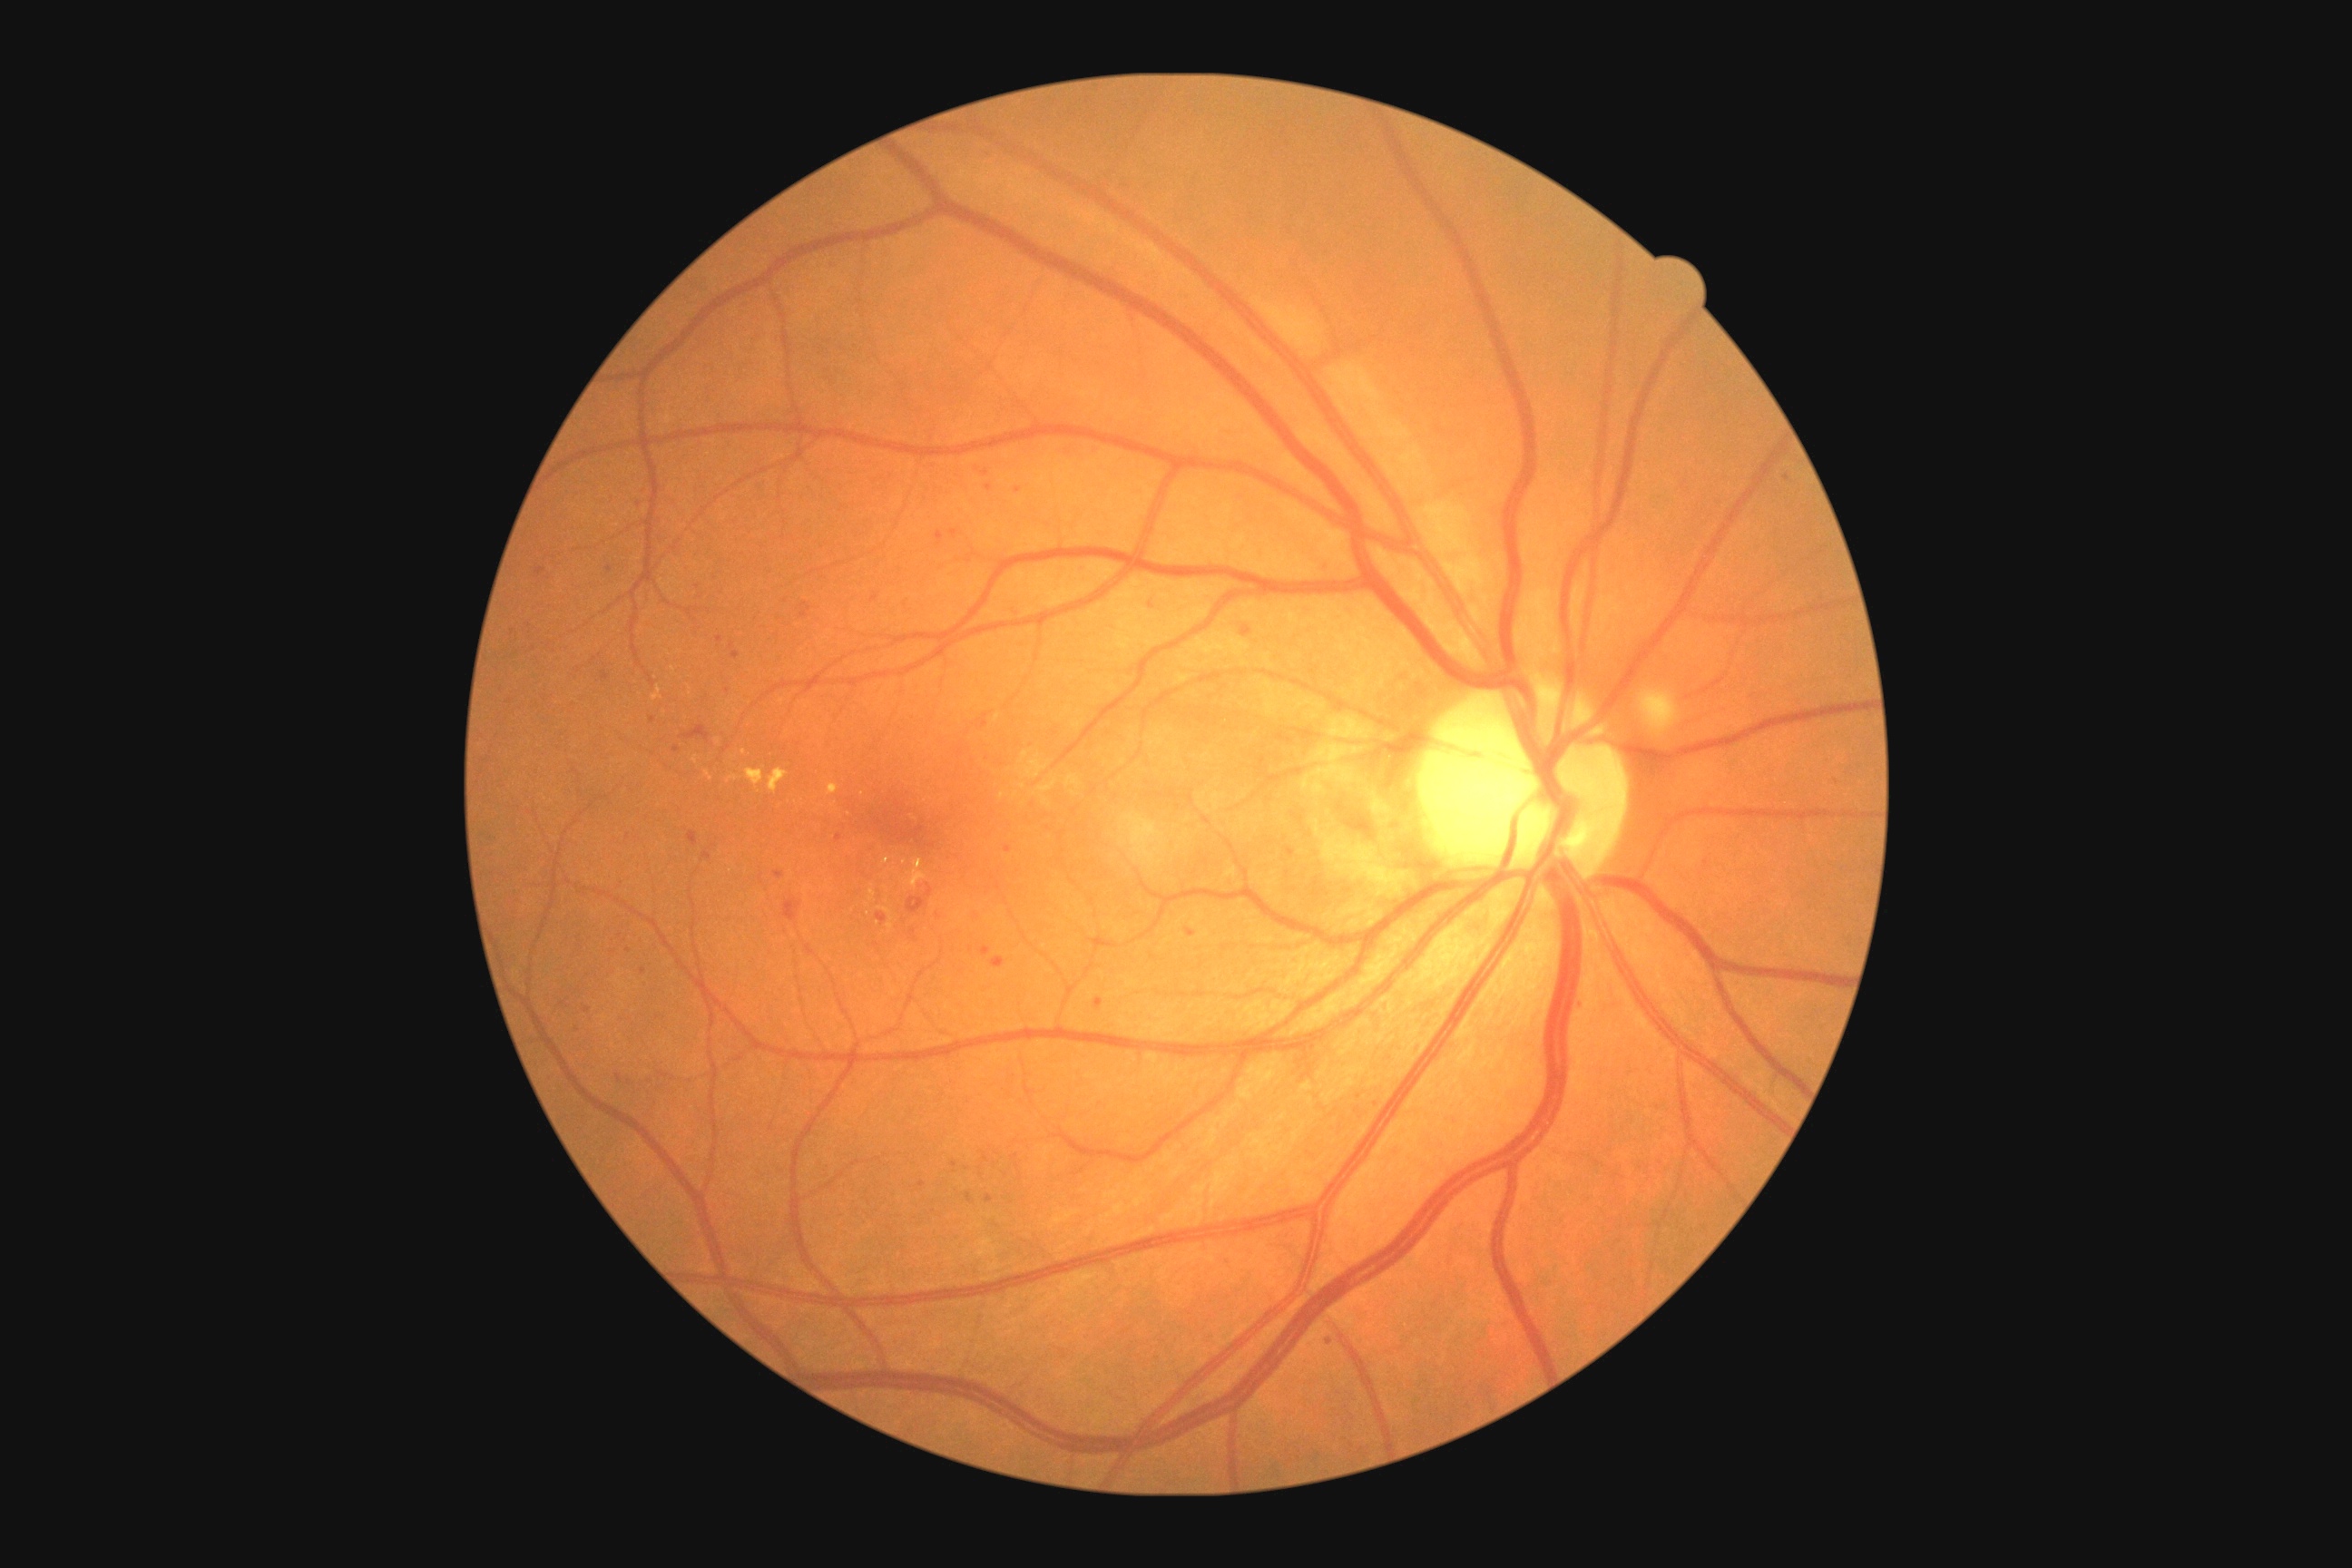

<lesions partial="true">
  <dr_grade>2</dr_grade>
  <ma partial="true">bbox=[836, 834, 843, 843]; bbox=[536, 567, 545, 576]; bbox=[616, 1075, 622, 1083]; bbox=[701, 852, 712, 861]; bbox=[1015, 611, 1023, 616]; bbox=[985, 1153, 990, 1162]; bbox=[1095, 999, 1104, 1008]; bbox=[672, 747, 680, 752]; bbox=[689, 832, 698, 847]; bbox=[986, 1195, 994, 1202]; bbox=[990, 957, 1004, 968]</ma>
  <ma_small_approx>986, 474; 1581, 1002; 1294, 853; 922, 1185; 621, 935</ma_small_approx>
  <se />
  <ex partial="true">bbox=[870, 890, 876, 901]; bbox=[745, 769, 765, 789]; bbox=[705, 770, 714, 781]; bbox=[906, 859, 926, 888]; bbox=[769, 769, 789, 794]; bbox=[652, 687, 662, 701]; bbox=[692, 756, 698, 765]; bbox=[828, 783, 839, 796]; bbox=[727, 776, 741, 783]</ex>
  <ex_small_approx>674, 669; 886, 861; 690, 694; 904, 863; 745, 753</ex_small_approx>
  <he>bbox=[925, 885, 934, 897]; bbox=[681, 725, 710, 741]; bbox=[783, 899, 803, 921]; bbox=[906, 896, 928, 916]</he>
</lesions>